848 by 848 pixels; NIDEK AFC-230; diabetic retinopathy graded by the modified Davis classification.
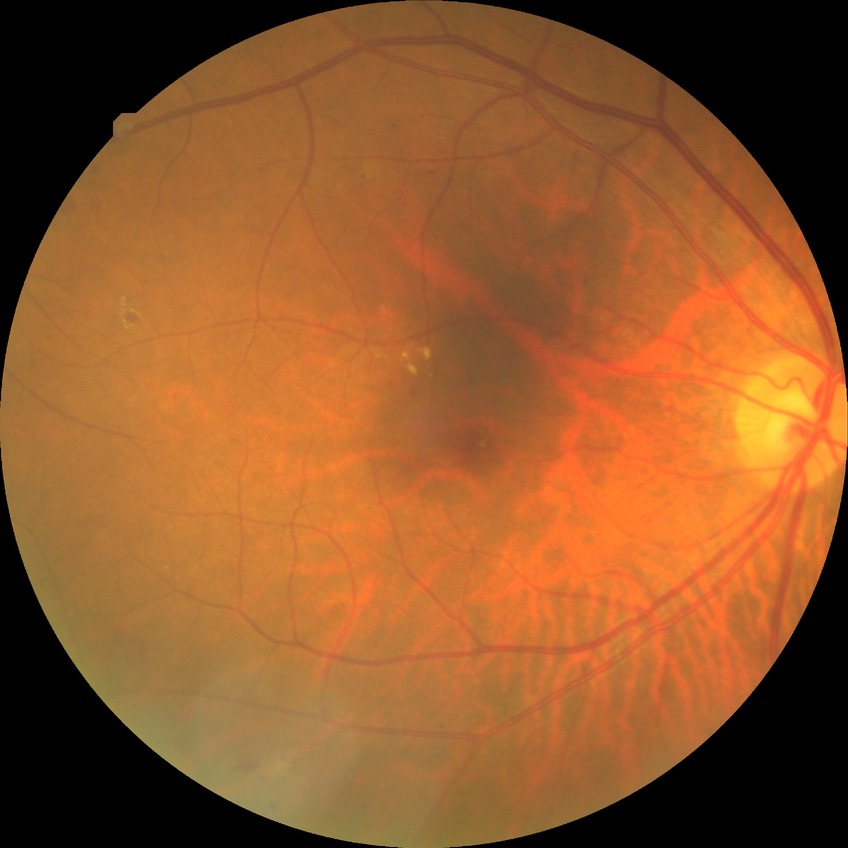 Diabetic retinopathy (DR) is simple diabetic retinopathy (SDR).